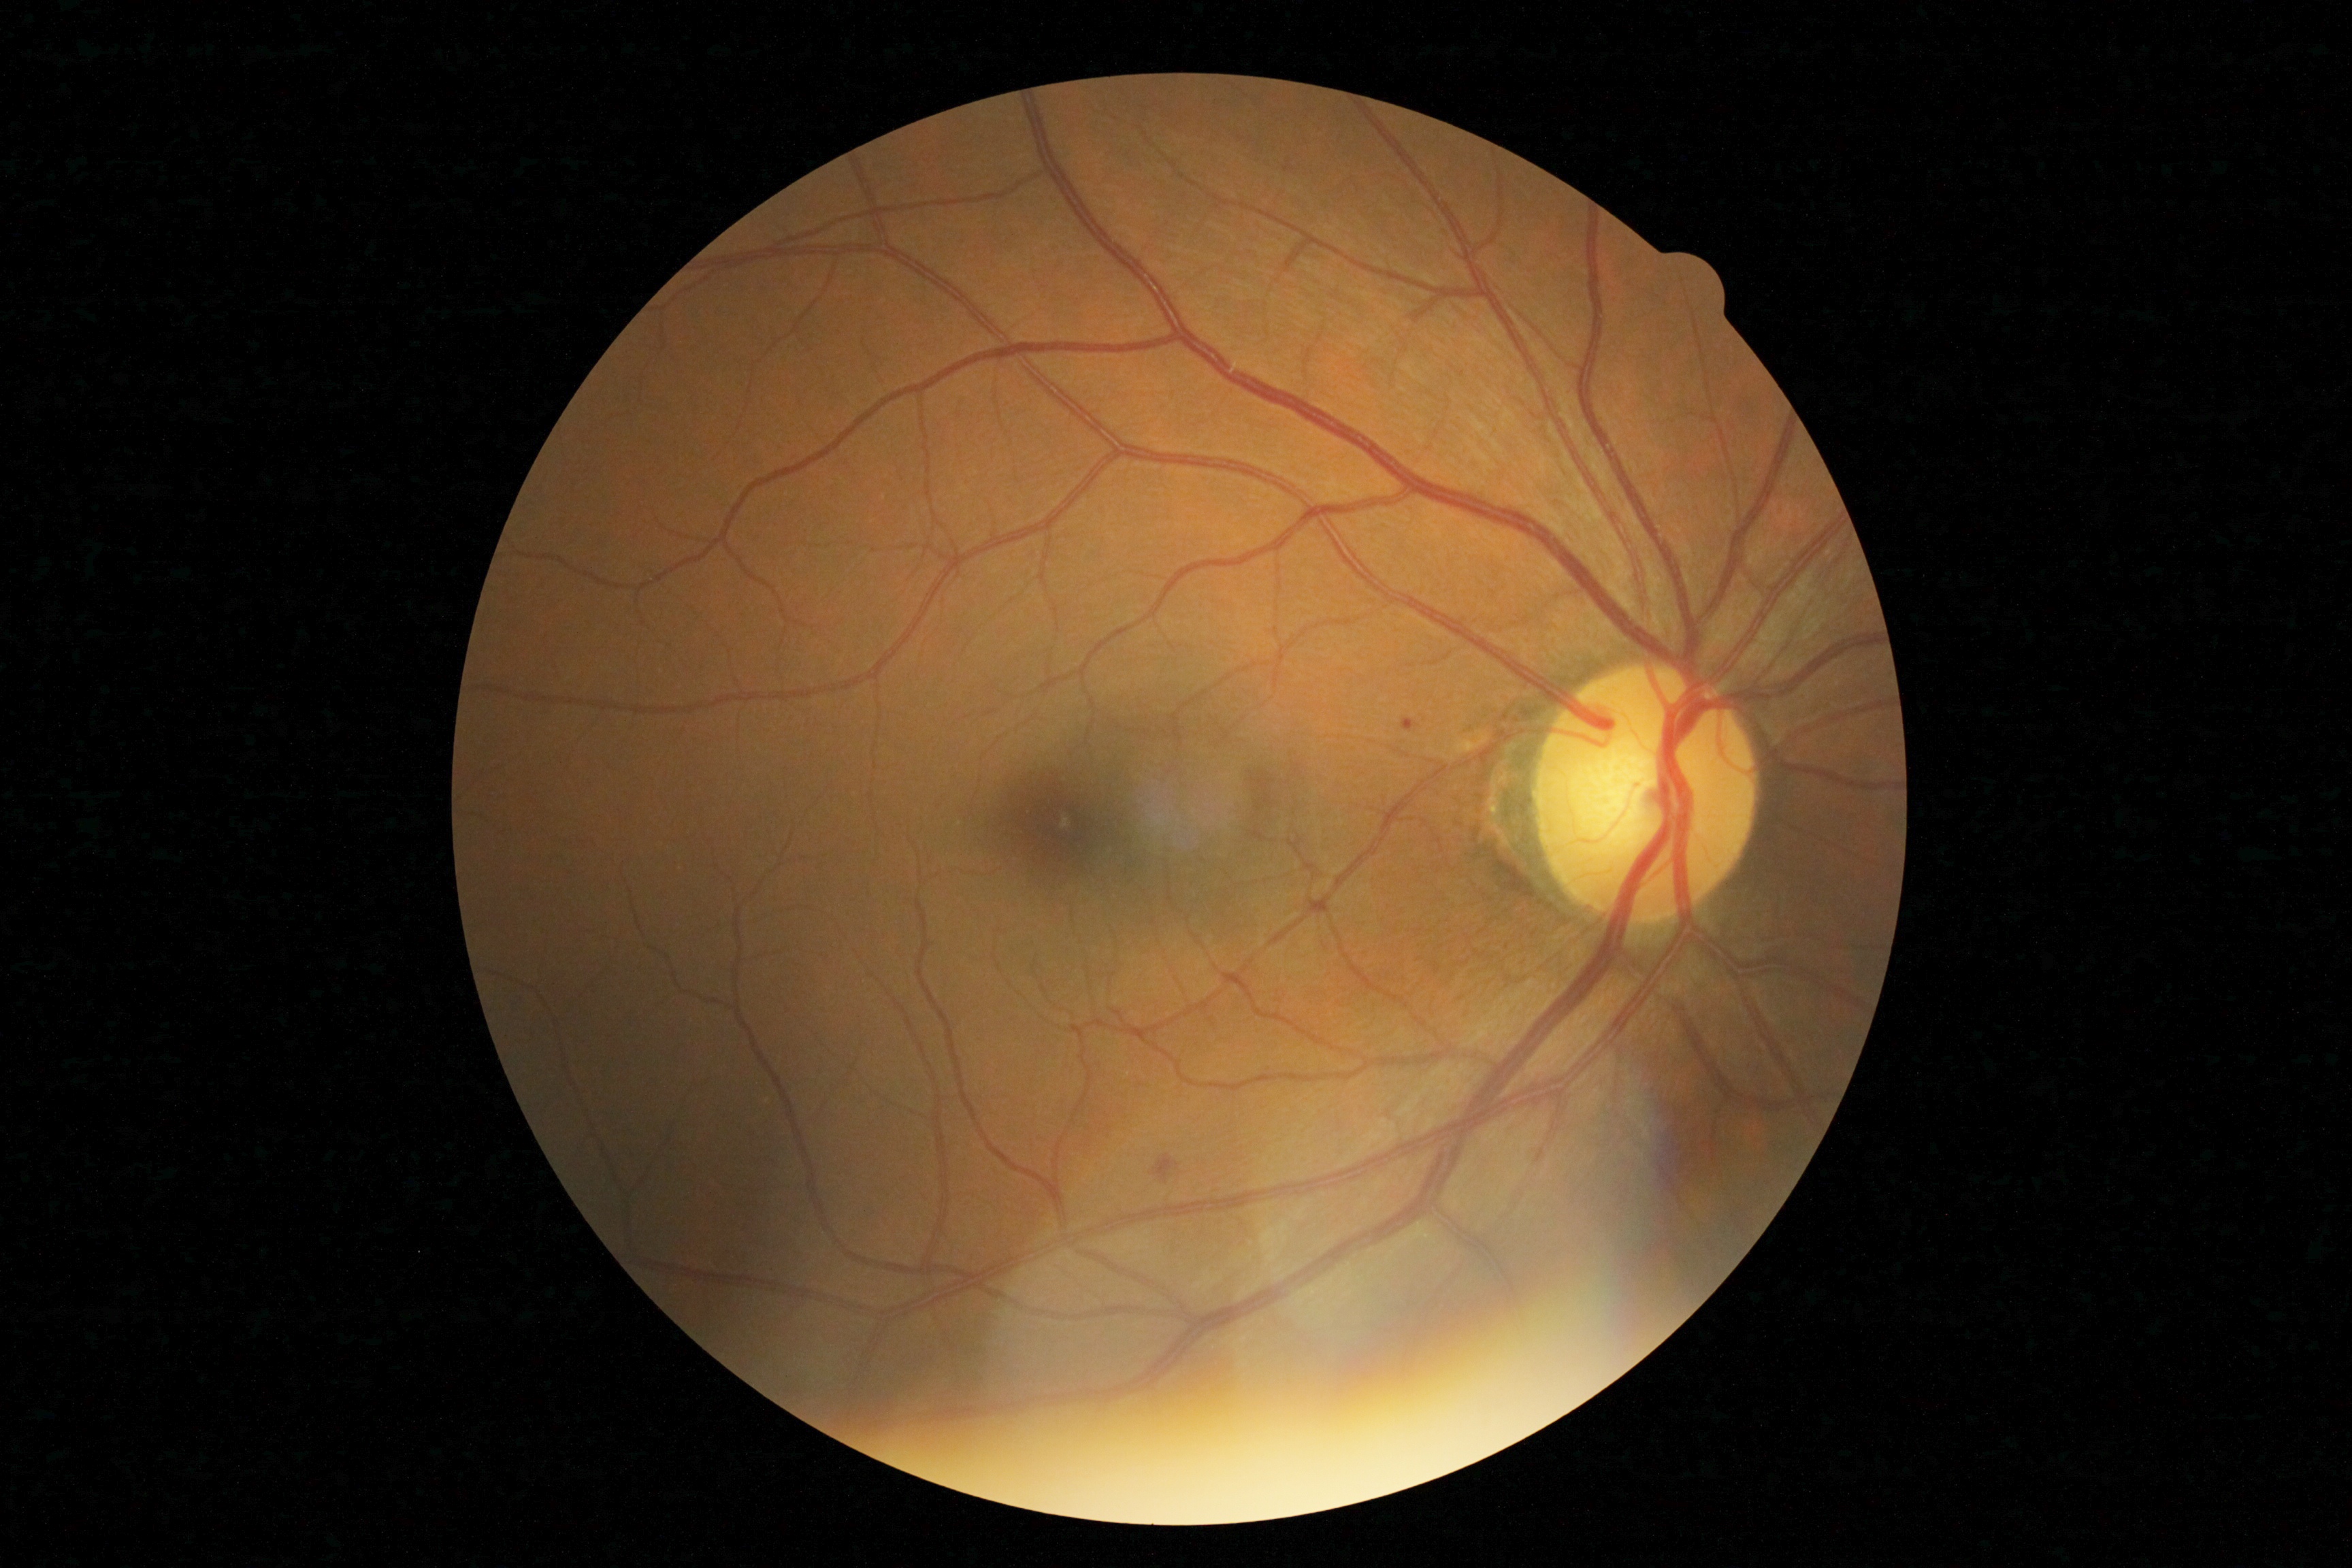
{
  "dr_grade": "1"
}